Fundus photo · 2102 x 1736 pixels.
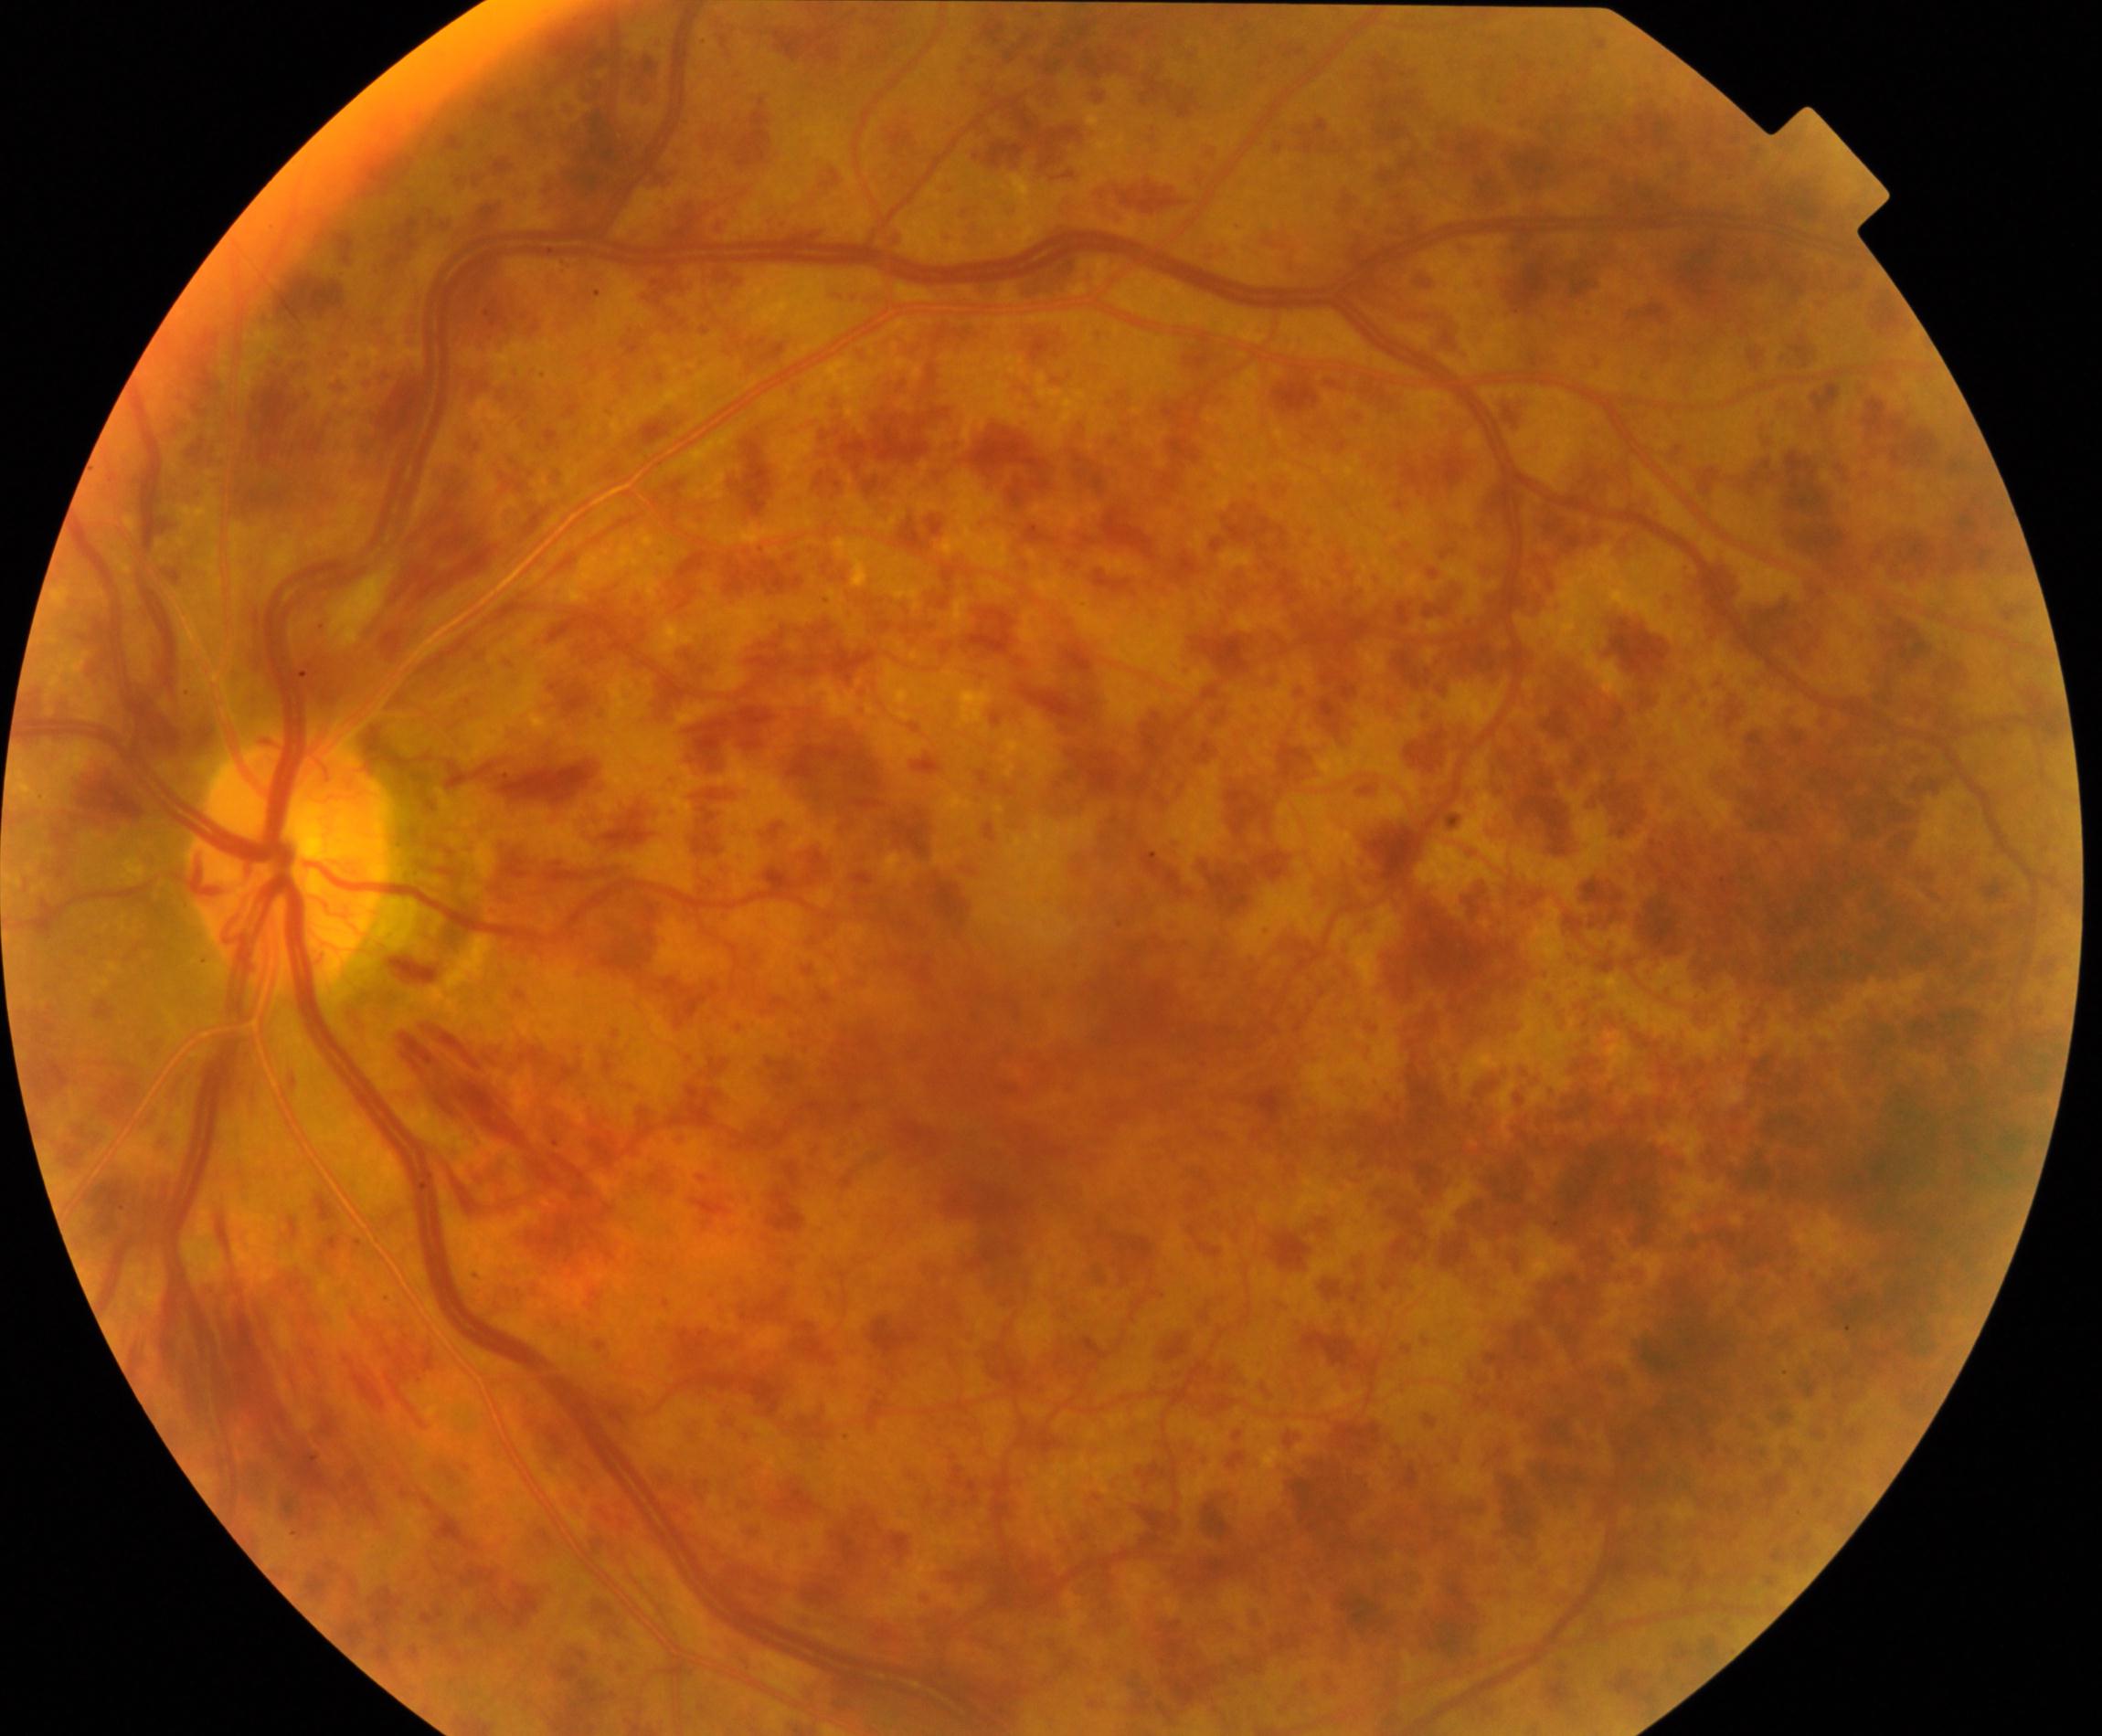

Consistent with central retinal vein occlusion.